FOV: 45 degrees · CFP.
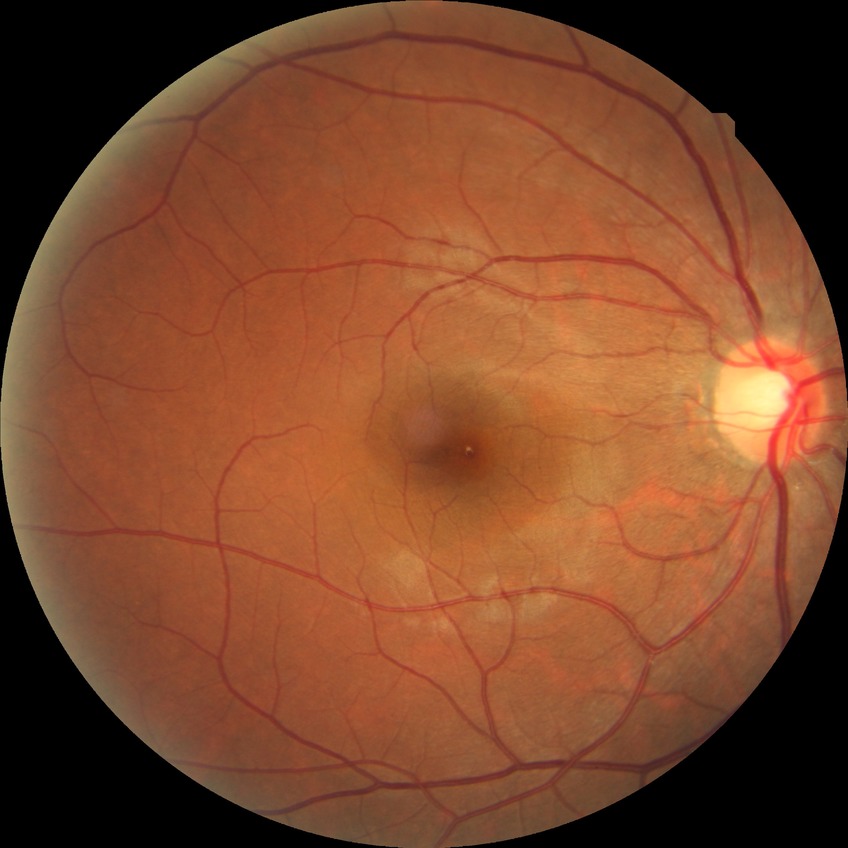
  davis_grade: NDR (no diabetic retinopathy)